Without pupil dilation.
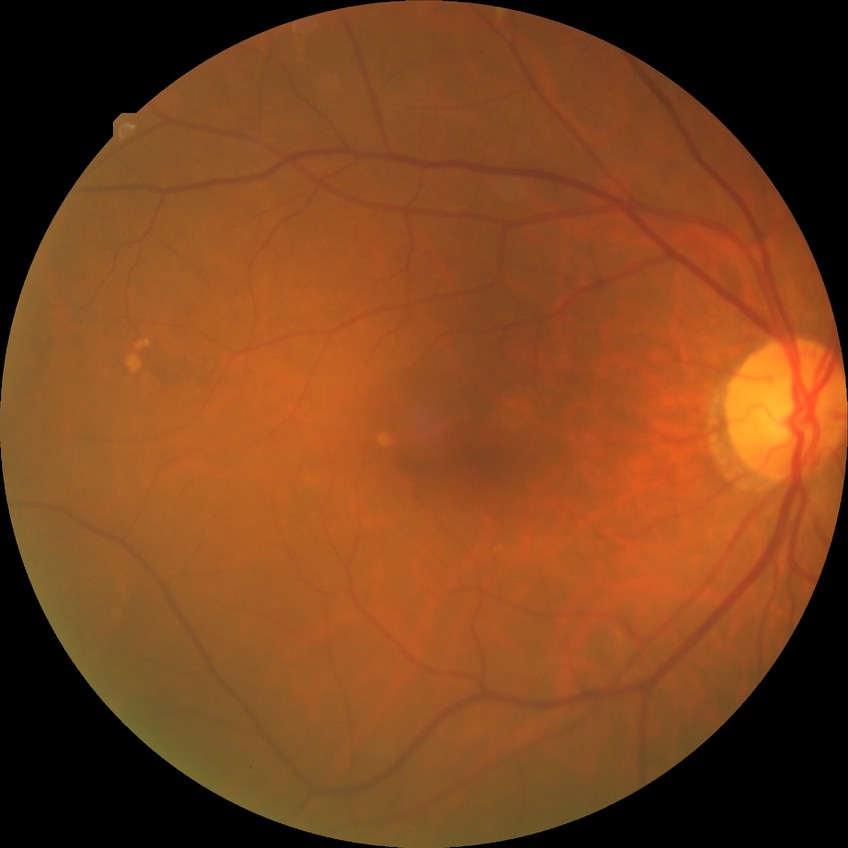
{"proliferative_class": "non-proliferative diabetic retinopathy", "davis_grade": "simple diabetic retinopathy (SDR)"}